Modified Davis grading
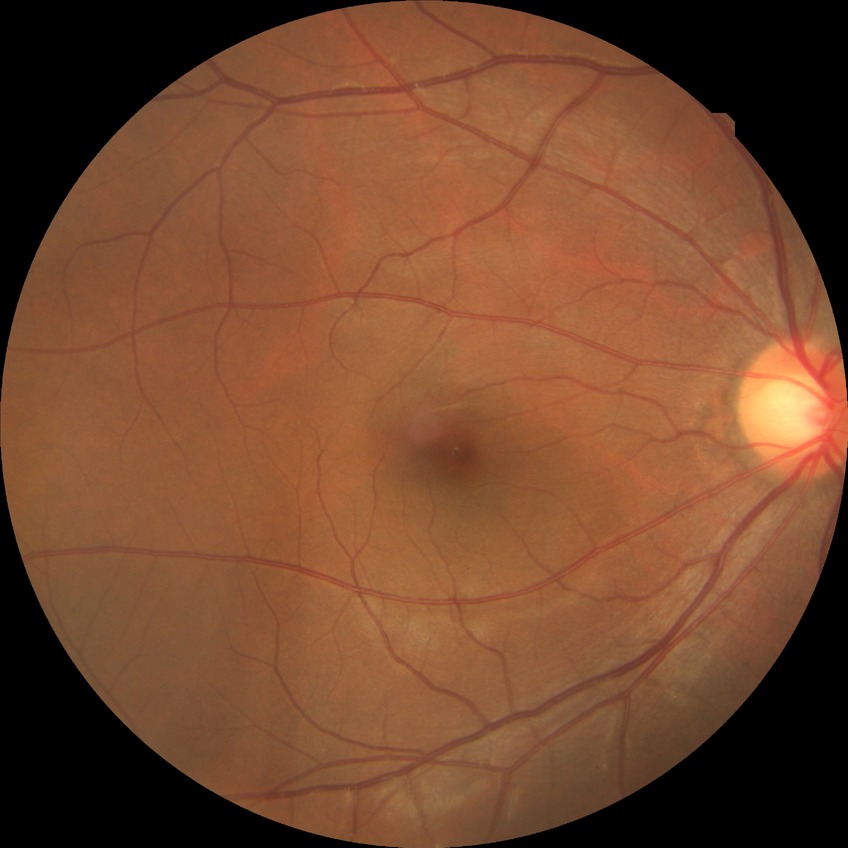
Davis grading: no diabetic retinopathy.